Color fundus image; image size 2352x1568.
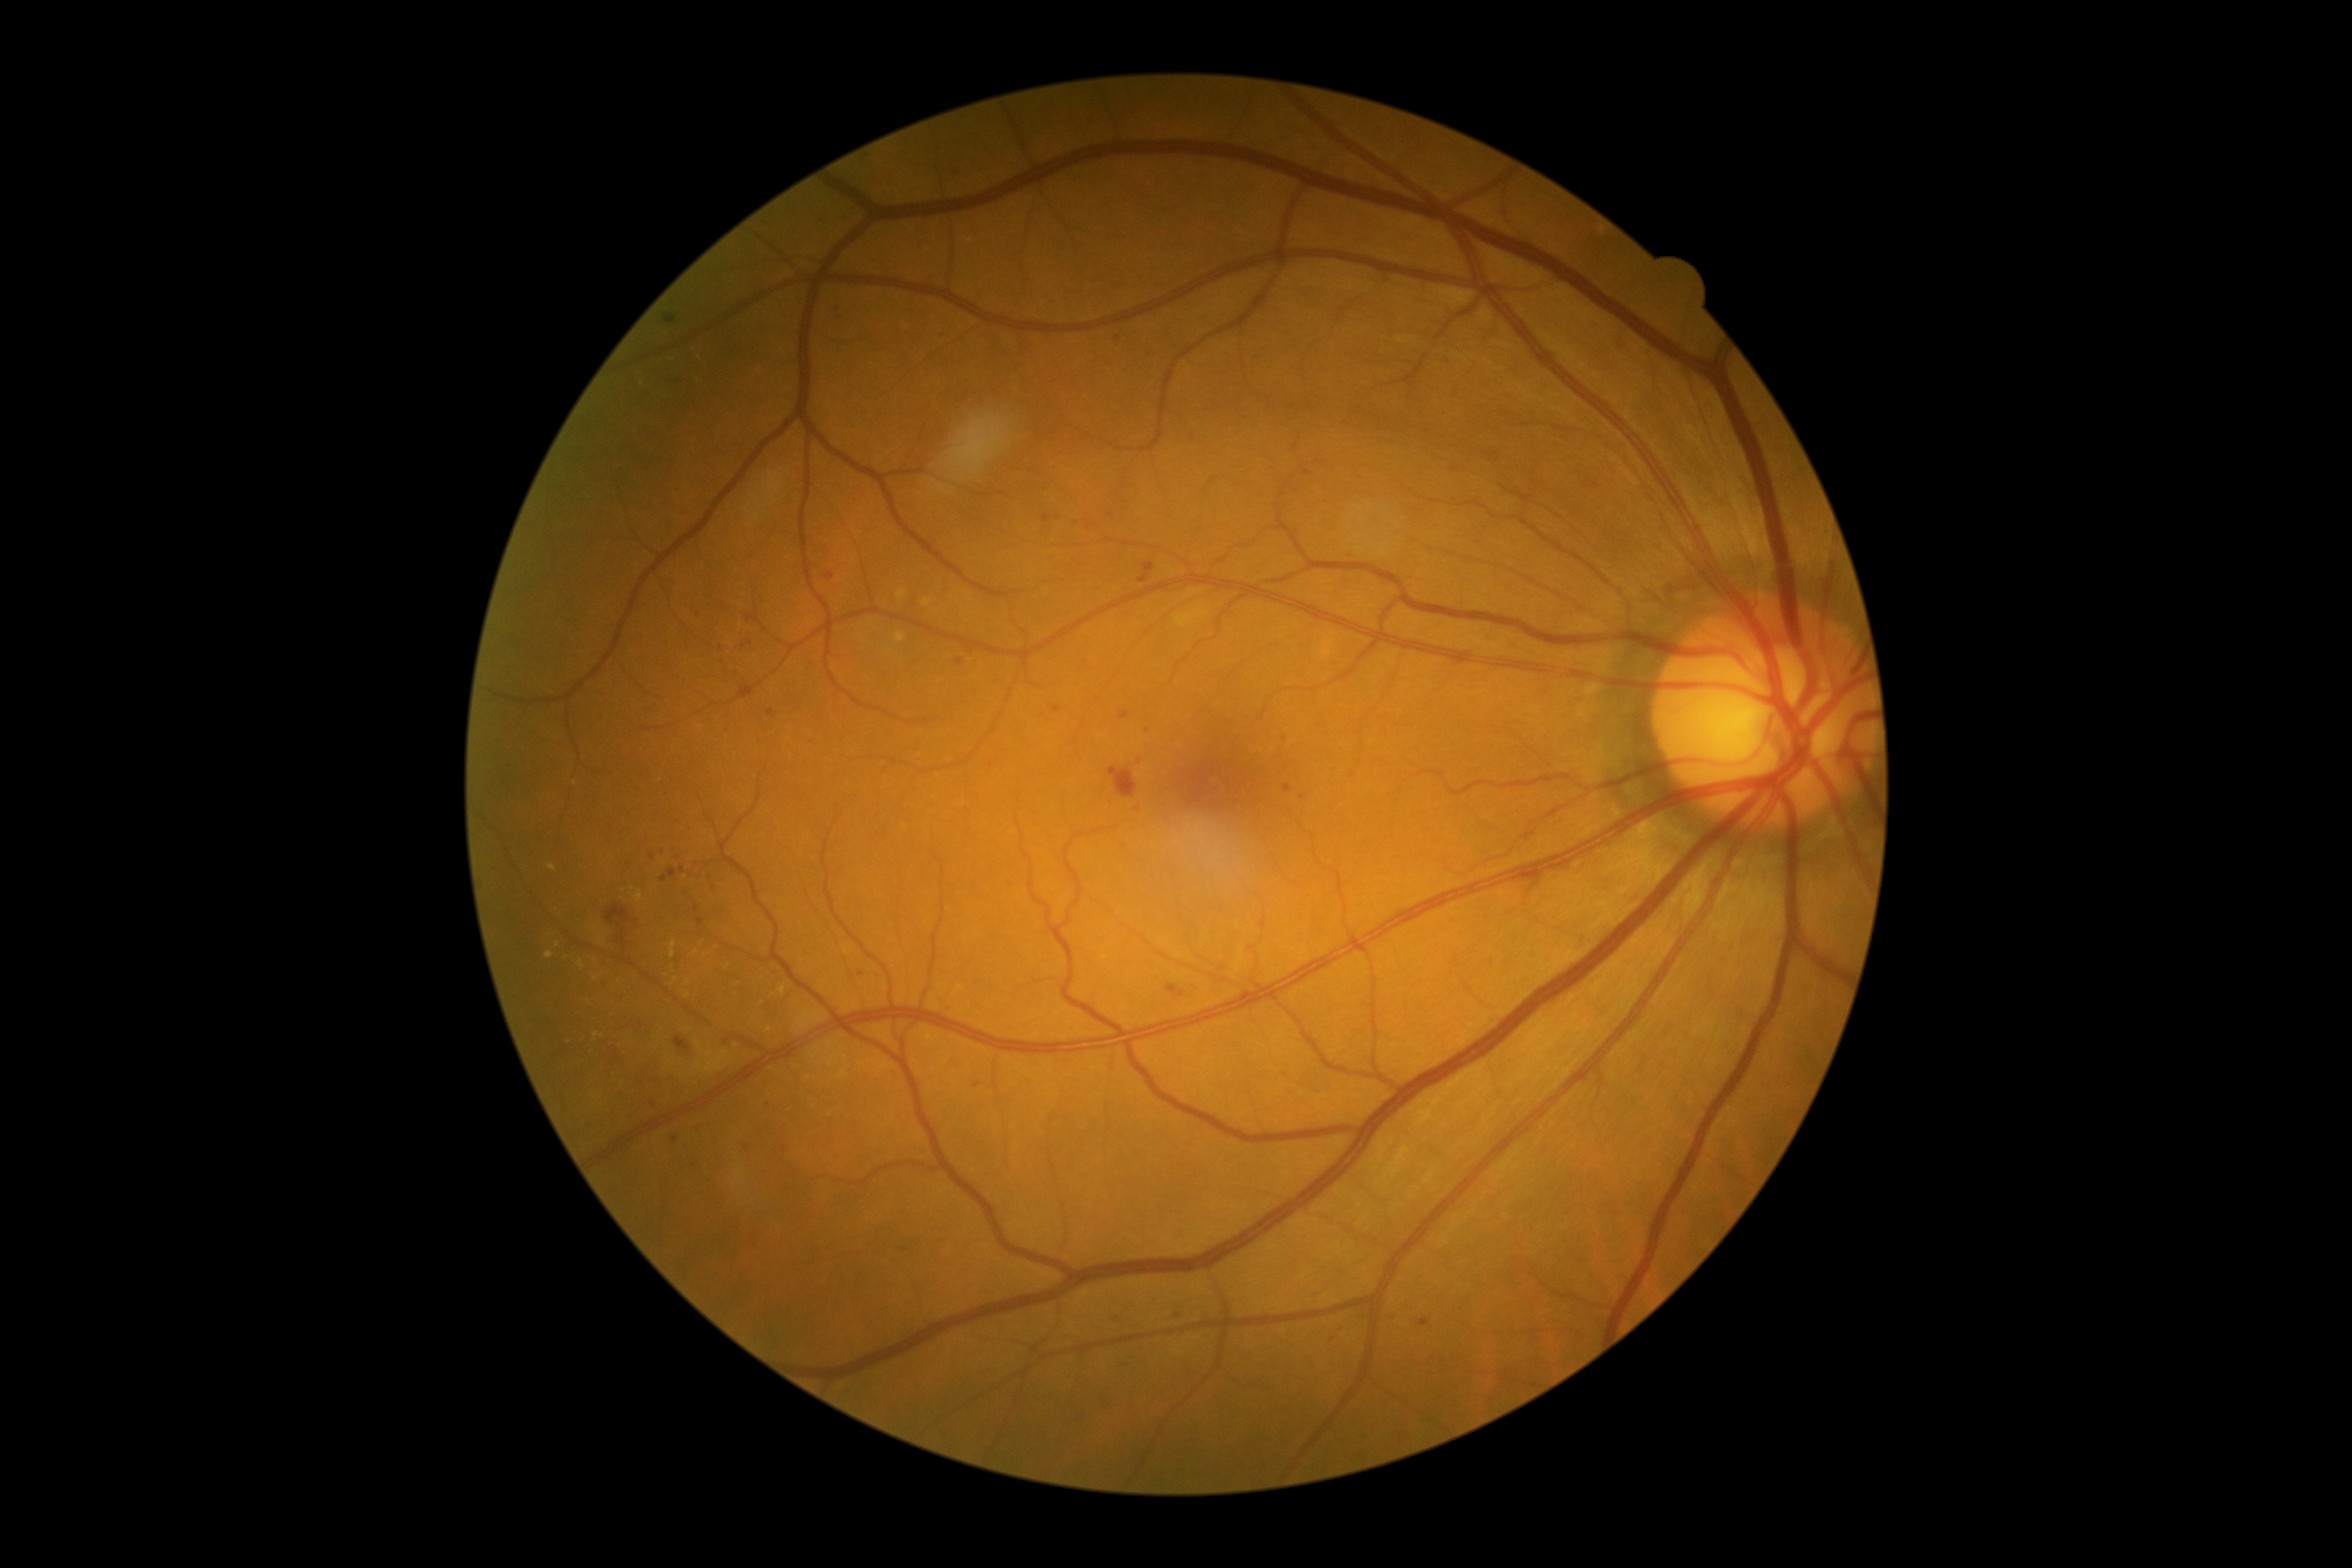

DR severity: 2.
MAs include l=666, t=315, r=677, b=324; l=687, t=888, r=692, b=897; l=697, t=917, r=704, b=928; l=957, t=658, r=964, b=666; l=697, t=609, r=701, b=620; l=1139, t=561, r=1156, b=584; l=1282, t=785, r=1292, b=793.
MAs (small, approximate centers) near pt(861, 974); pt(1147, 730); pt(1117, 338); pt(1138, 809); pt(652, 858); pt(714, 888); pt(736, 673); pt(1303, 798); pt(699, 1133); pt(1178, 1316); pt(771, 712); pt(682, 870).
EXs include l=579, t=960, r=584, b=969; l=637, t=891, r=644, b=903; l=780, t=986, r=787, b=996; l=670, t=941, r=677, b=959; l=546, t=952, r=554, b=960.
EXs (small, approximate centers) near pt(904, 827); pt(673, 967); pt(769, 1030); pt(675, 980); pt(570, 1042); pt(595, 927); pt(566, 958); pt(552, 869); pt(696, 953); pt(558, 945); pt(687, 995); pt(596, 1037); pt(595, 978); pt(600, 939); pt(688, 982).
No SEs identified.
HEs at l=673, t=1038, r=690, b=1055; l=606, t=905, r=639, b=928; l=616, t=929, r=628, b=950; l=1167, t=984, r=1185, b=998; l=1110, t=766, r=1139, b=800.